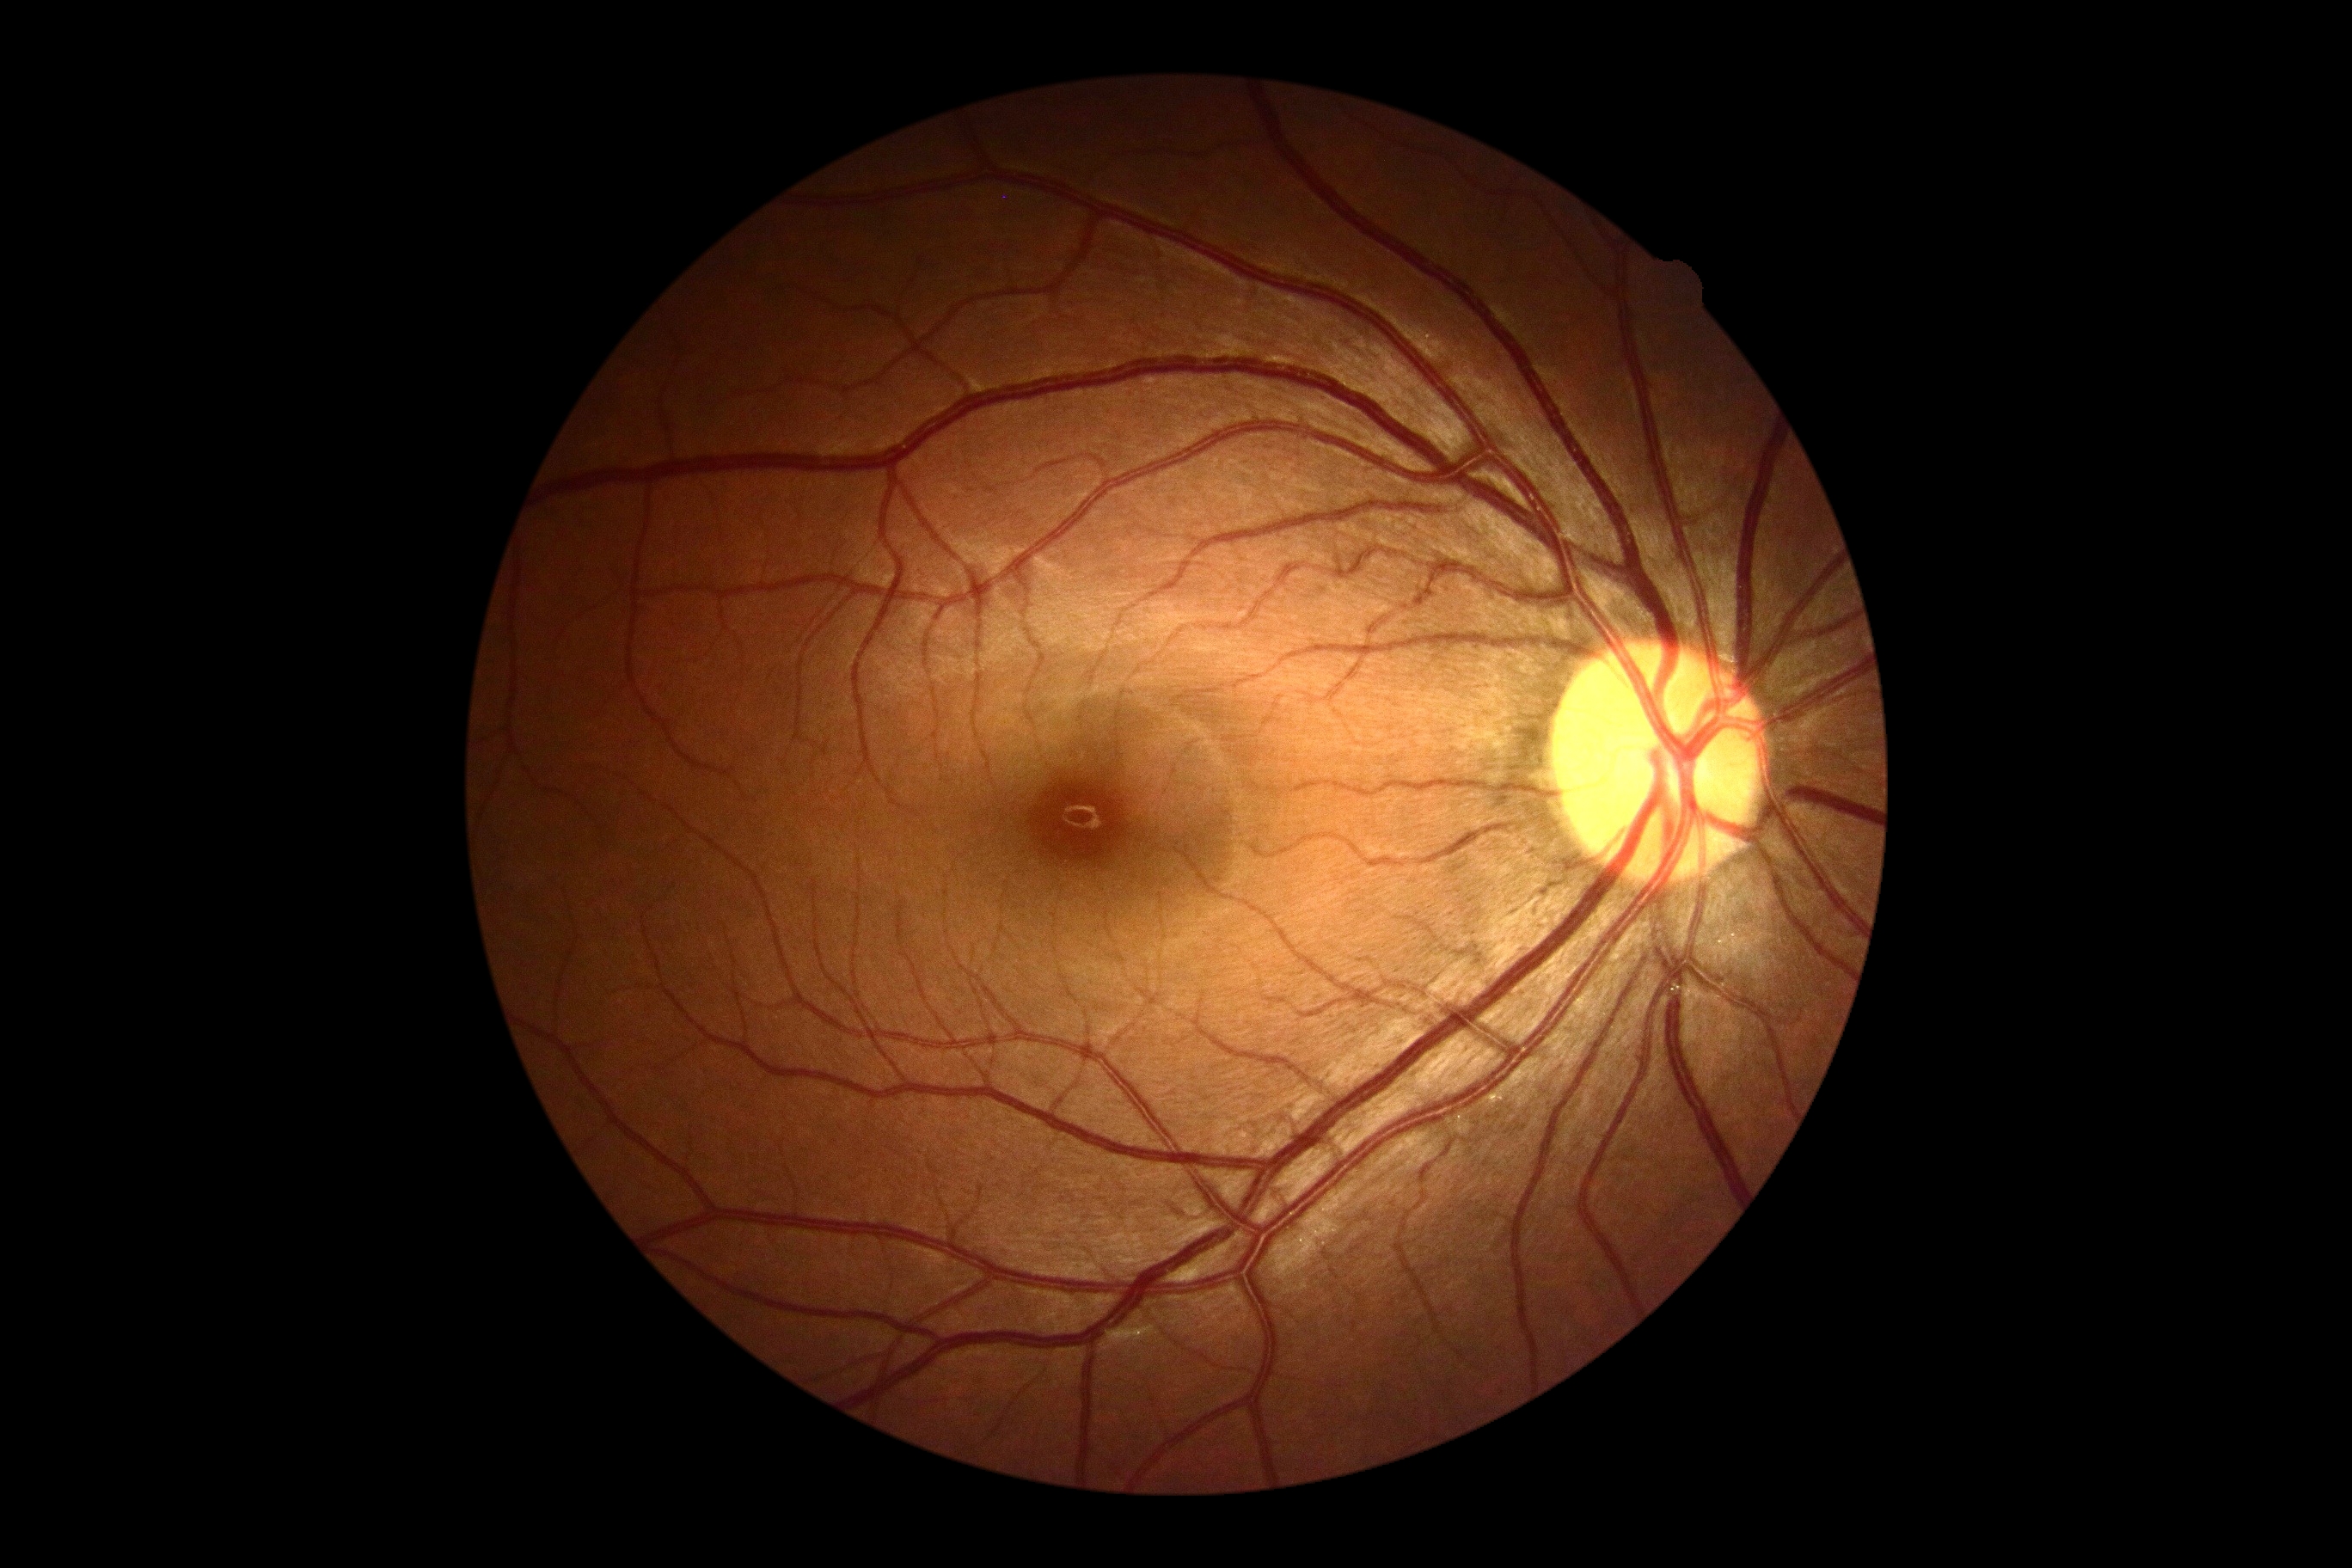 - diabetic retinopathy severity — grade 0 (no apparent retinopathy)